Captured on a Remidio Fundus on Phone · 1659 x 2212 pixels:
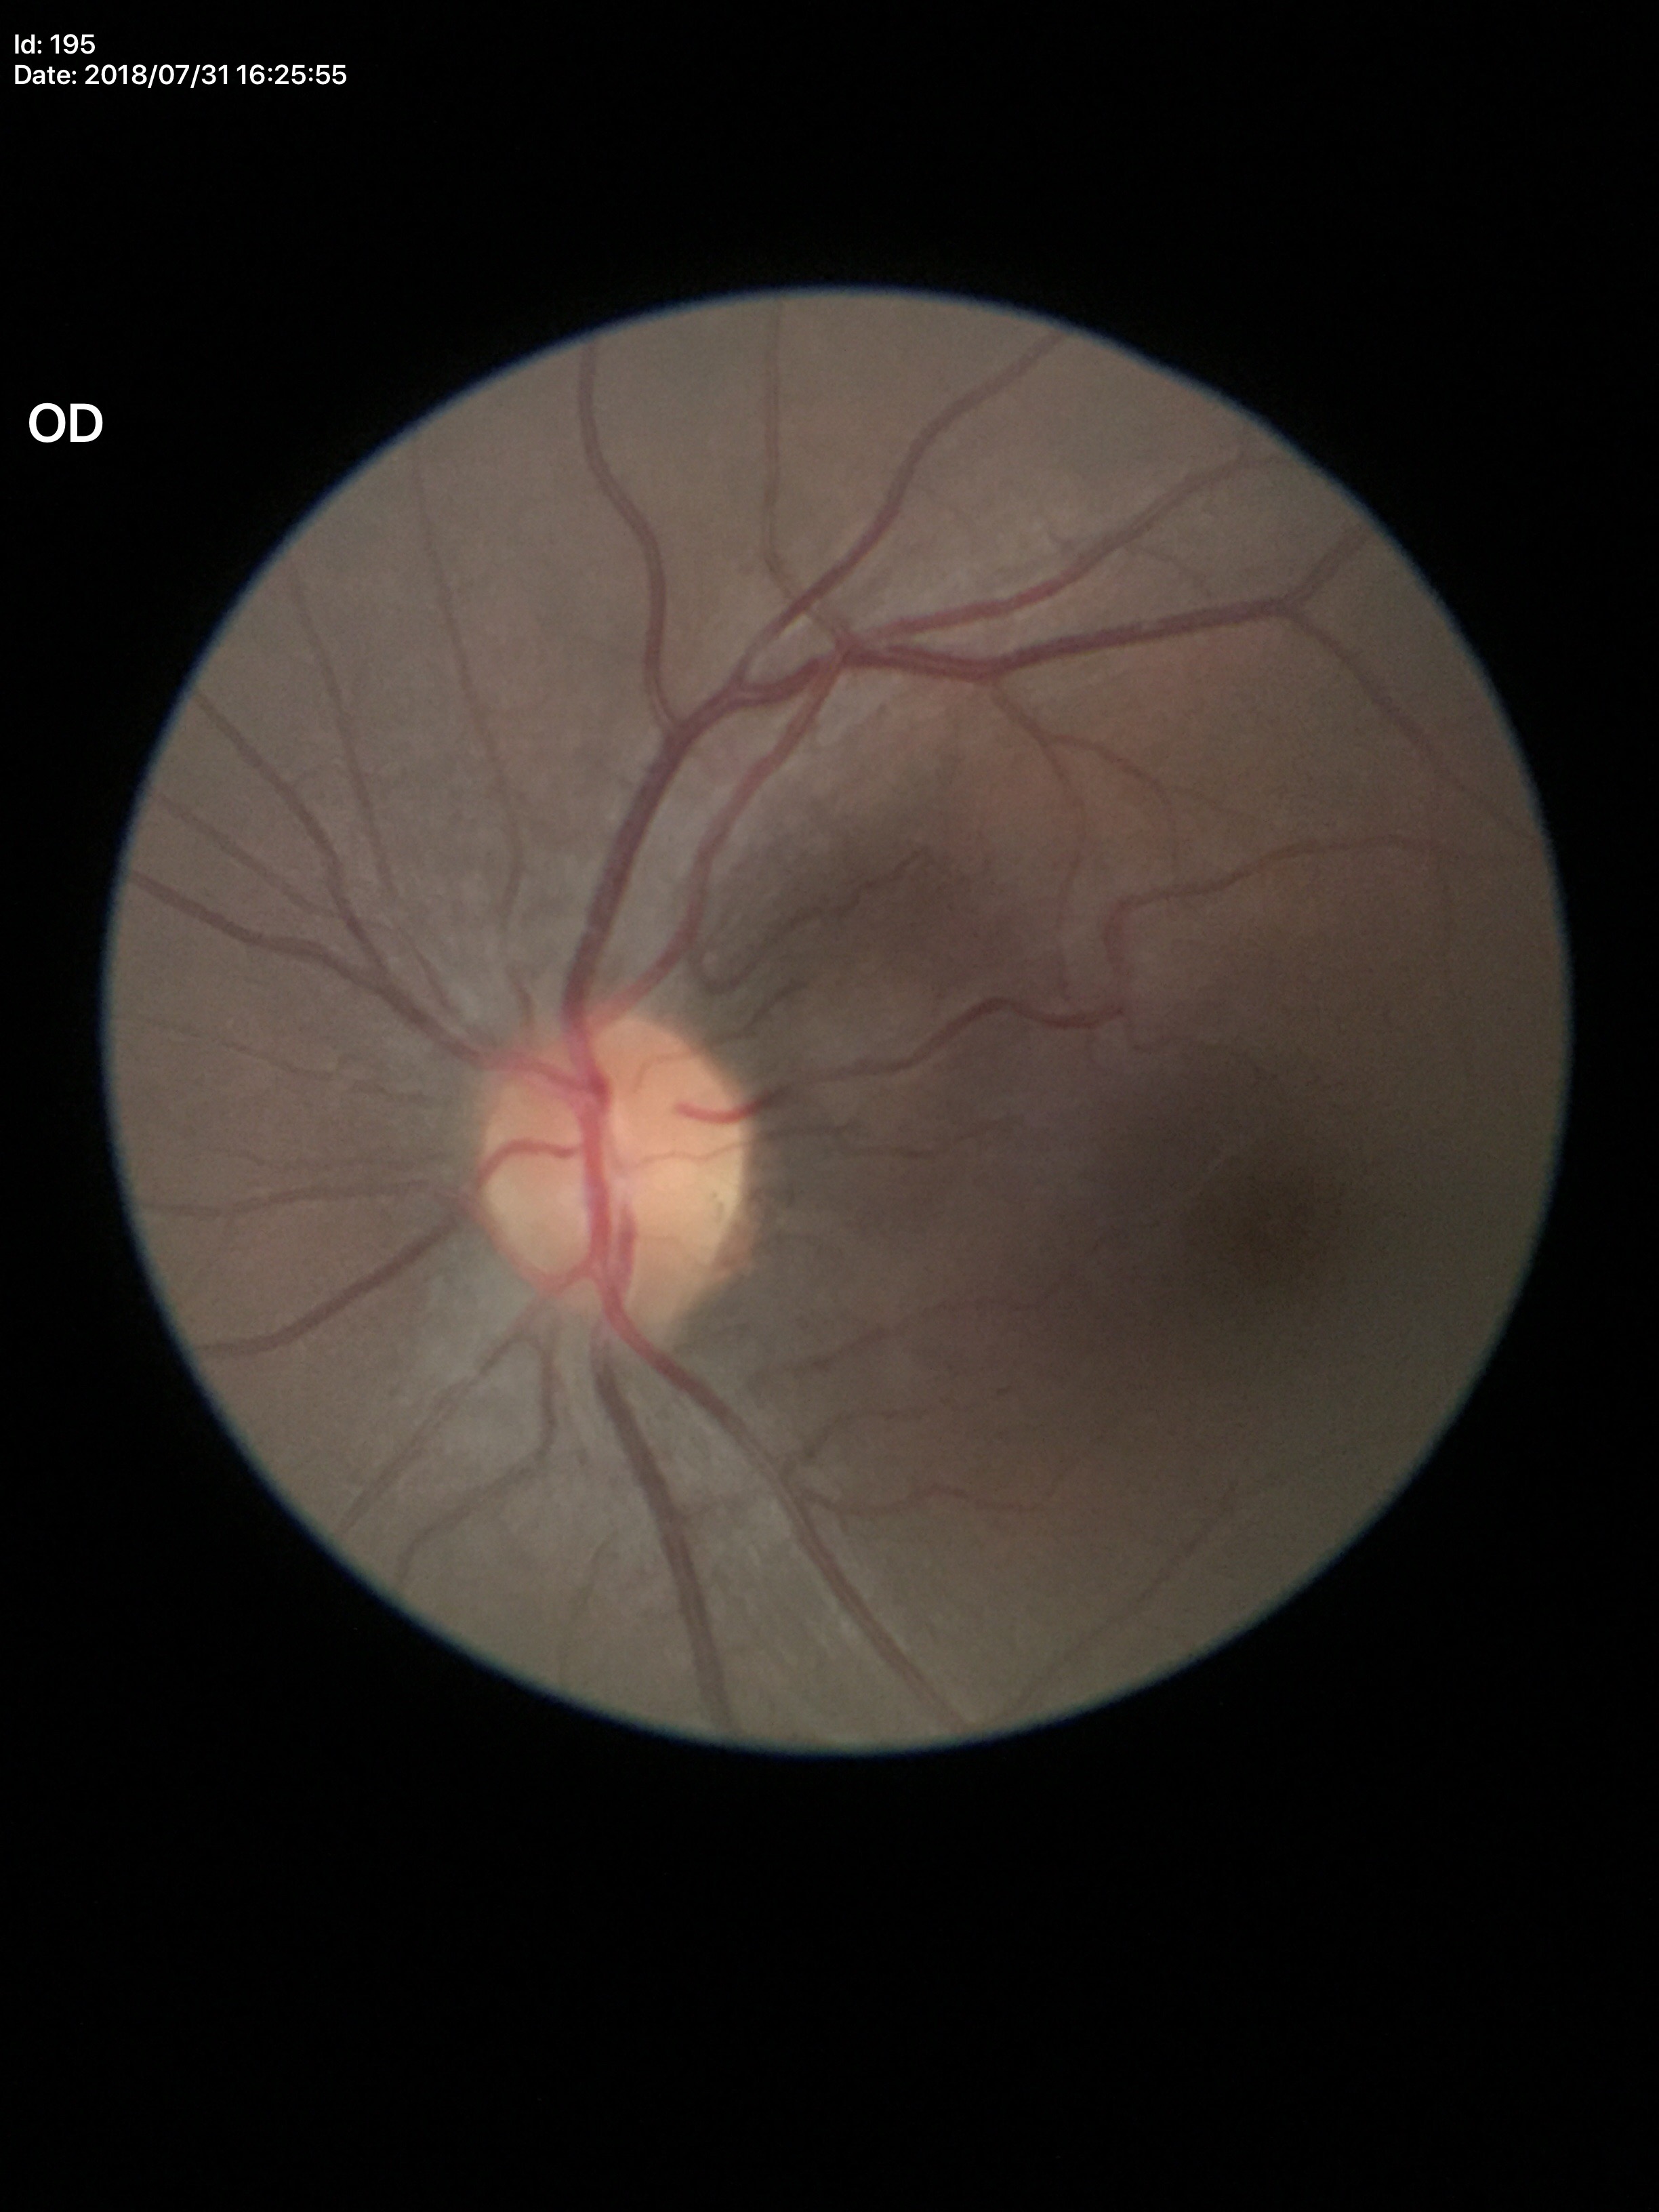

Glaucoma screening impression: negative.
Vertical cup-to-disc ratio (VCDR) is 0.41.